130° field of view (Natus RetCam Envision). Wide-field fundus image from infant ROP screening — 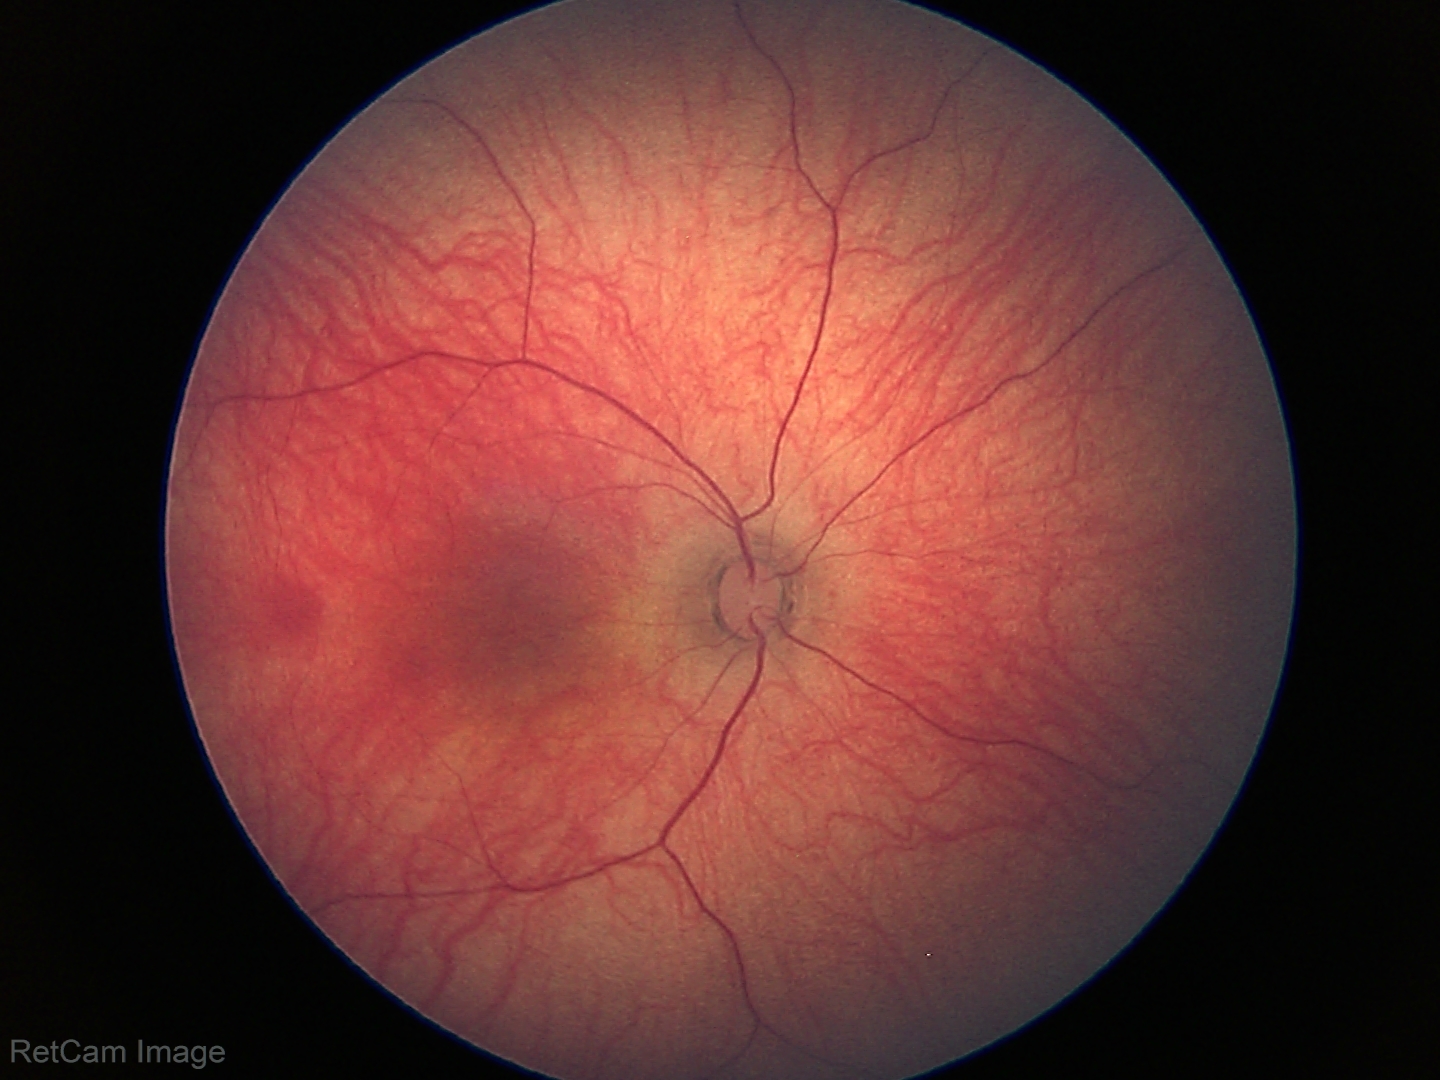
Finding: no pathology identified.